Pediatric retinal photograph (wide-field): 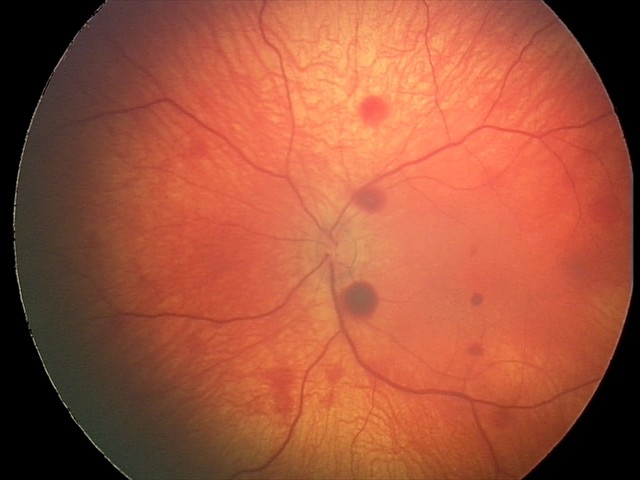 Screening series with retinal hemorrhages.